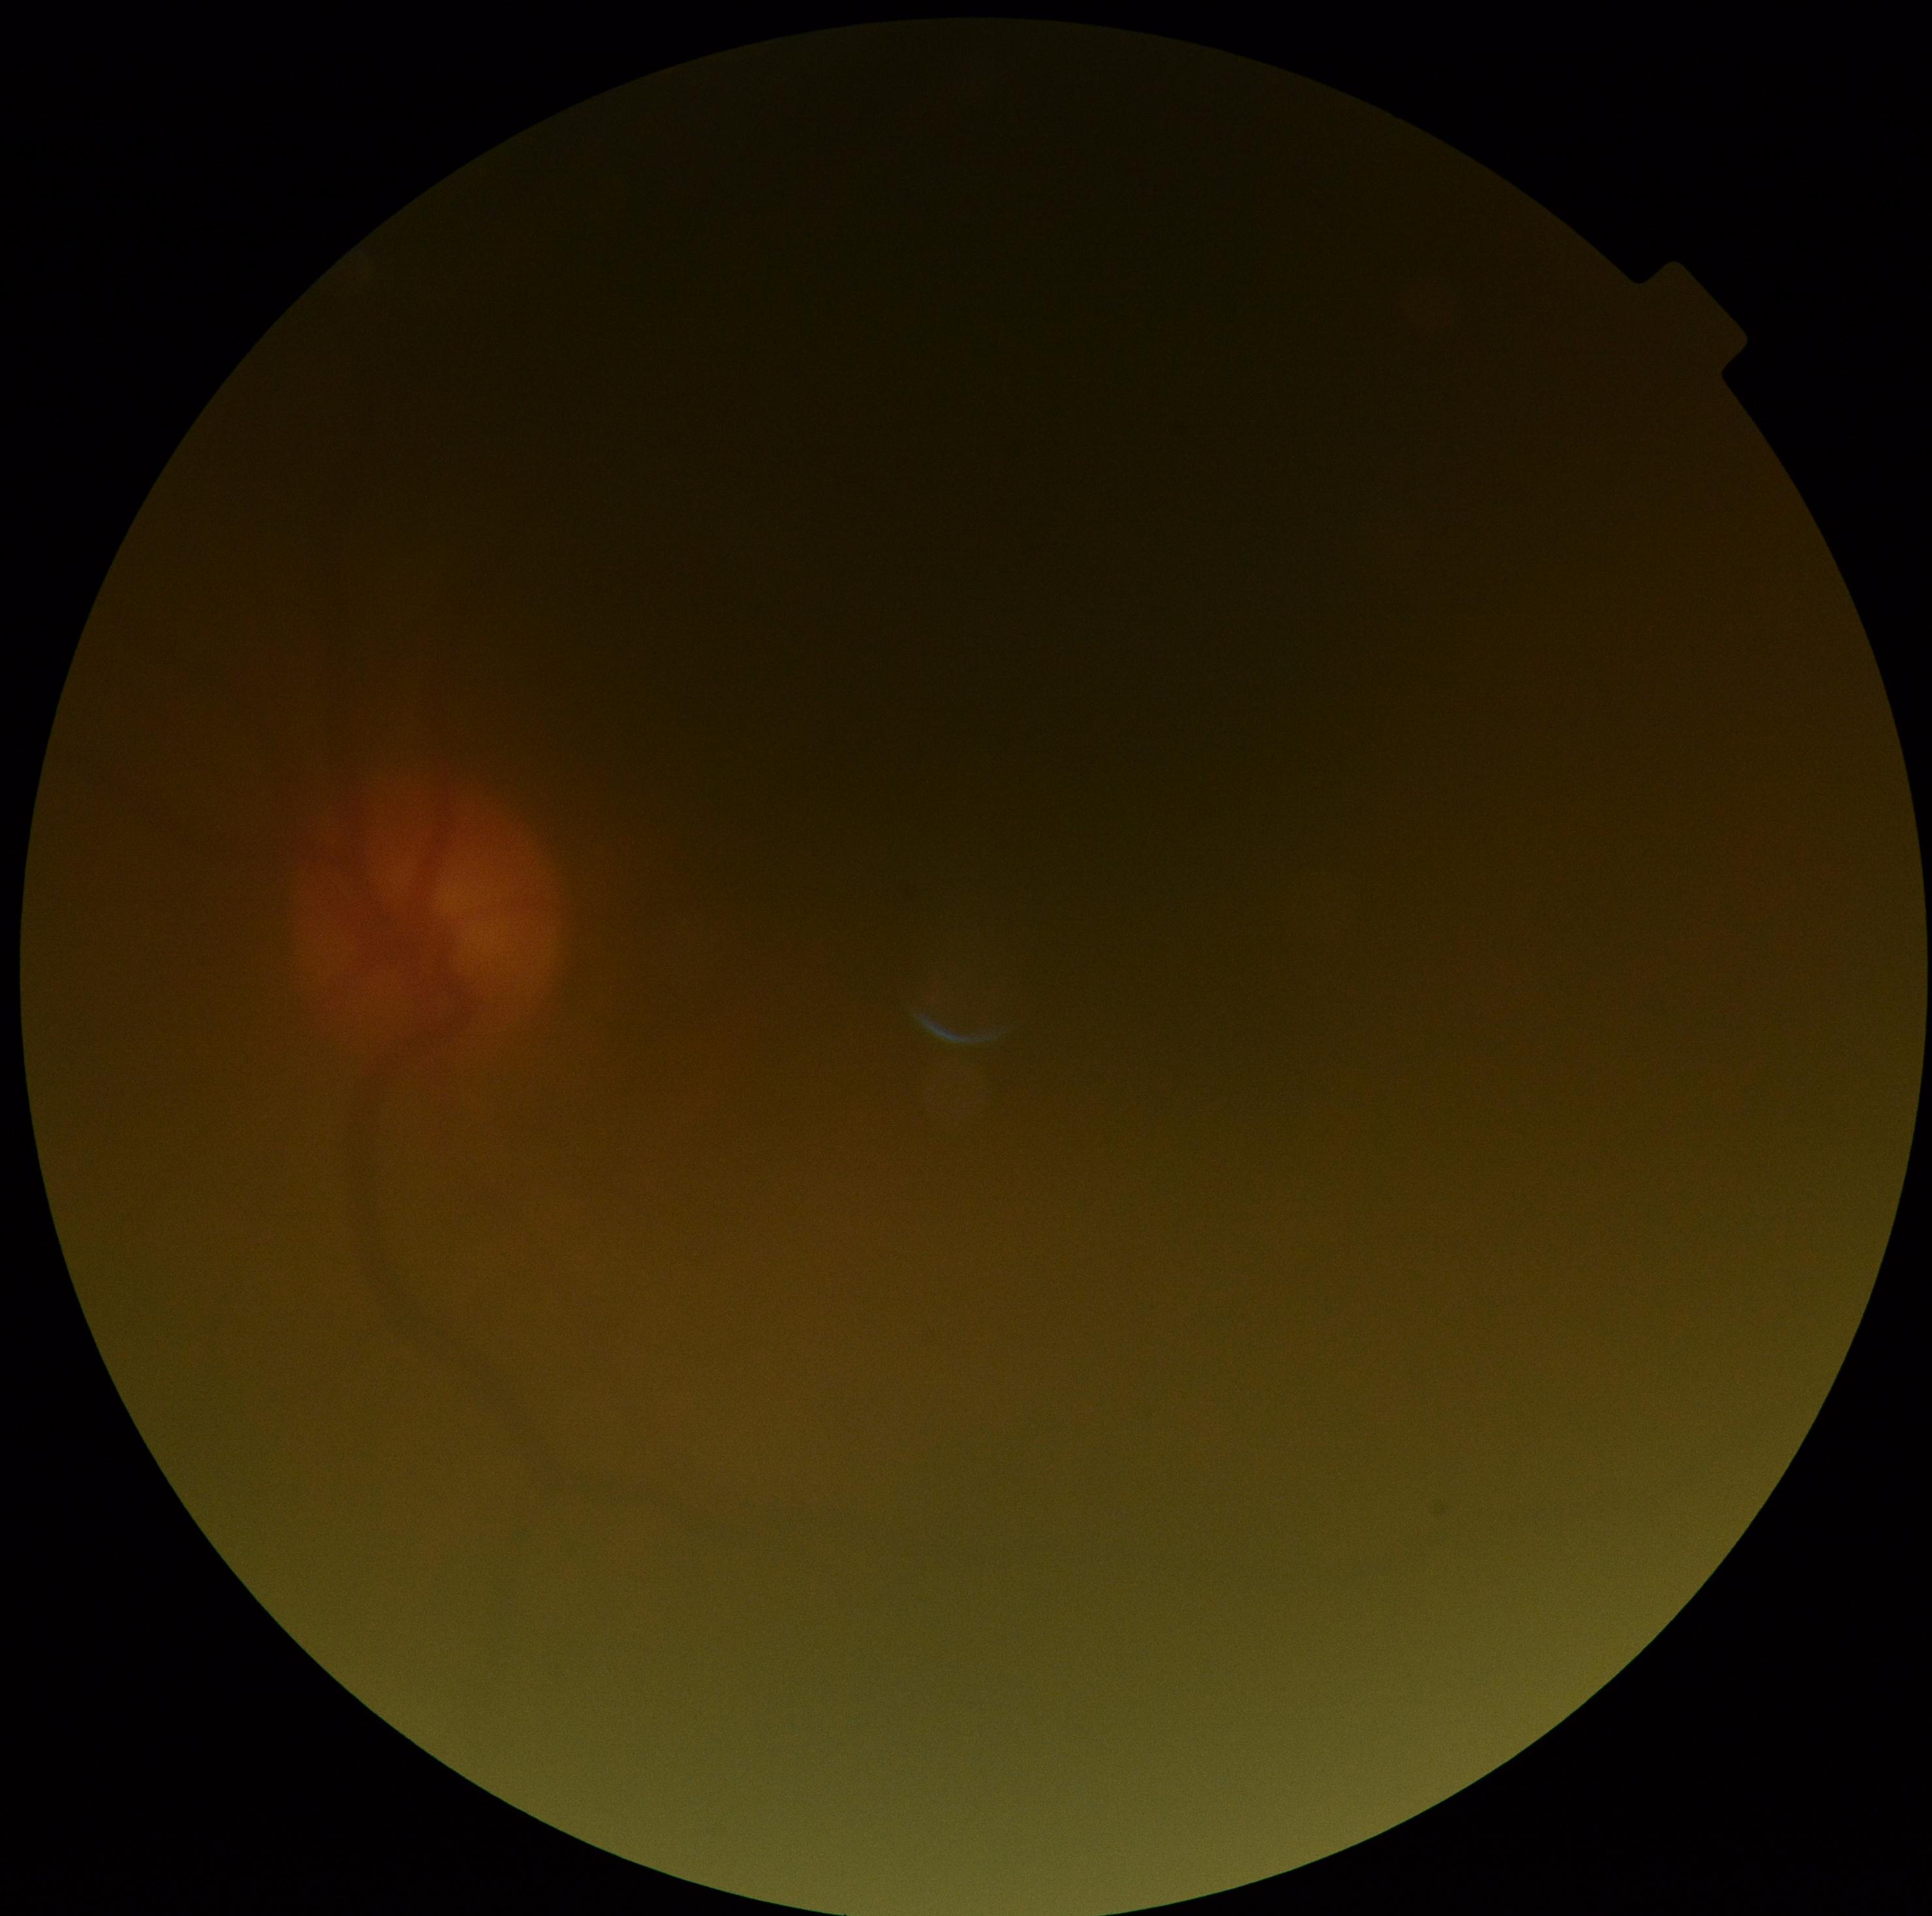 quality: below grading threshold
dr_grade: ungradable